640x480px; 130° field of view (Clarity RetCam 3); wide-field contact fundus photograph of an infant — 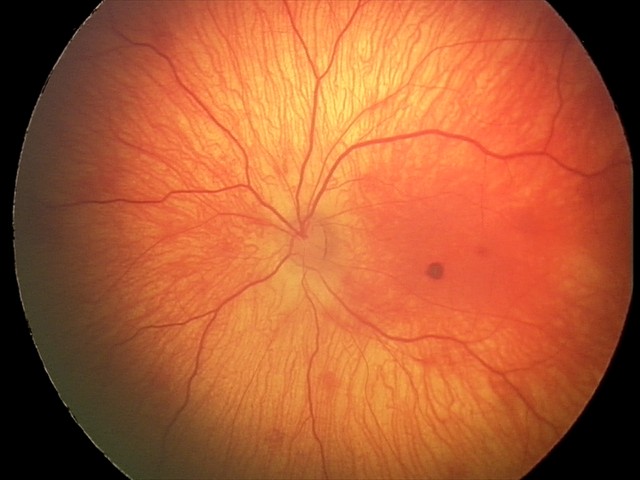
Screening examination consistent with retinal hemorrhages.